Nonmydriatic. NIDEK AFC-230 fundus camera
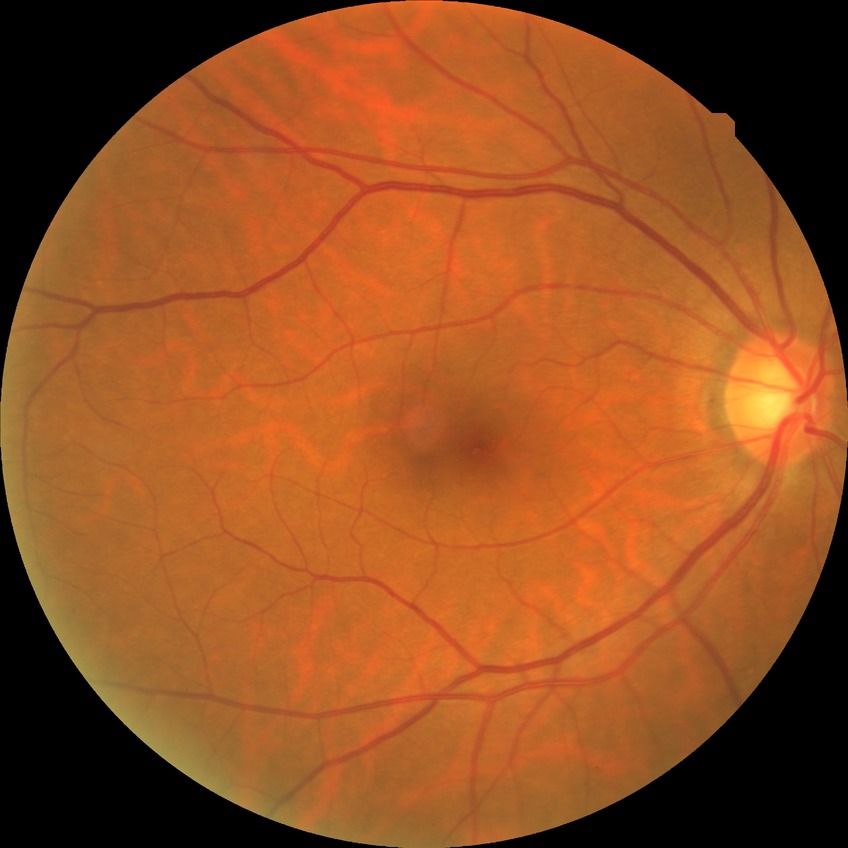 Diabetic retinopathy stage: no diabetic retinopathy.